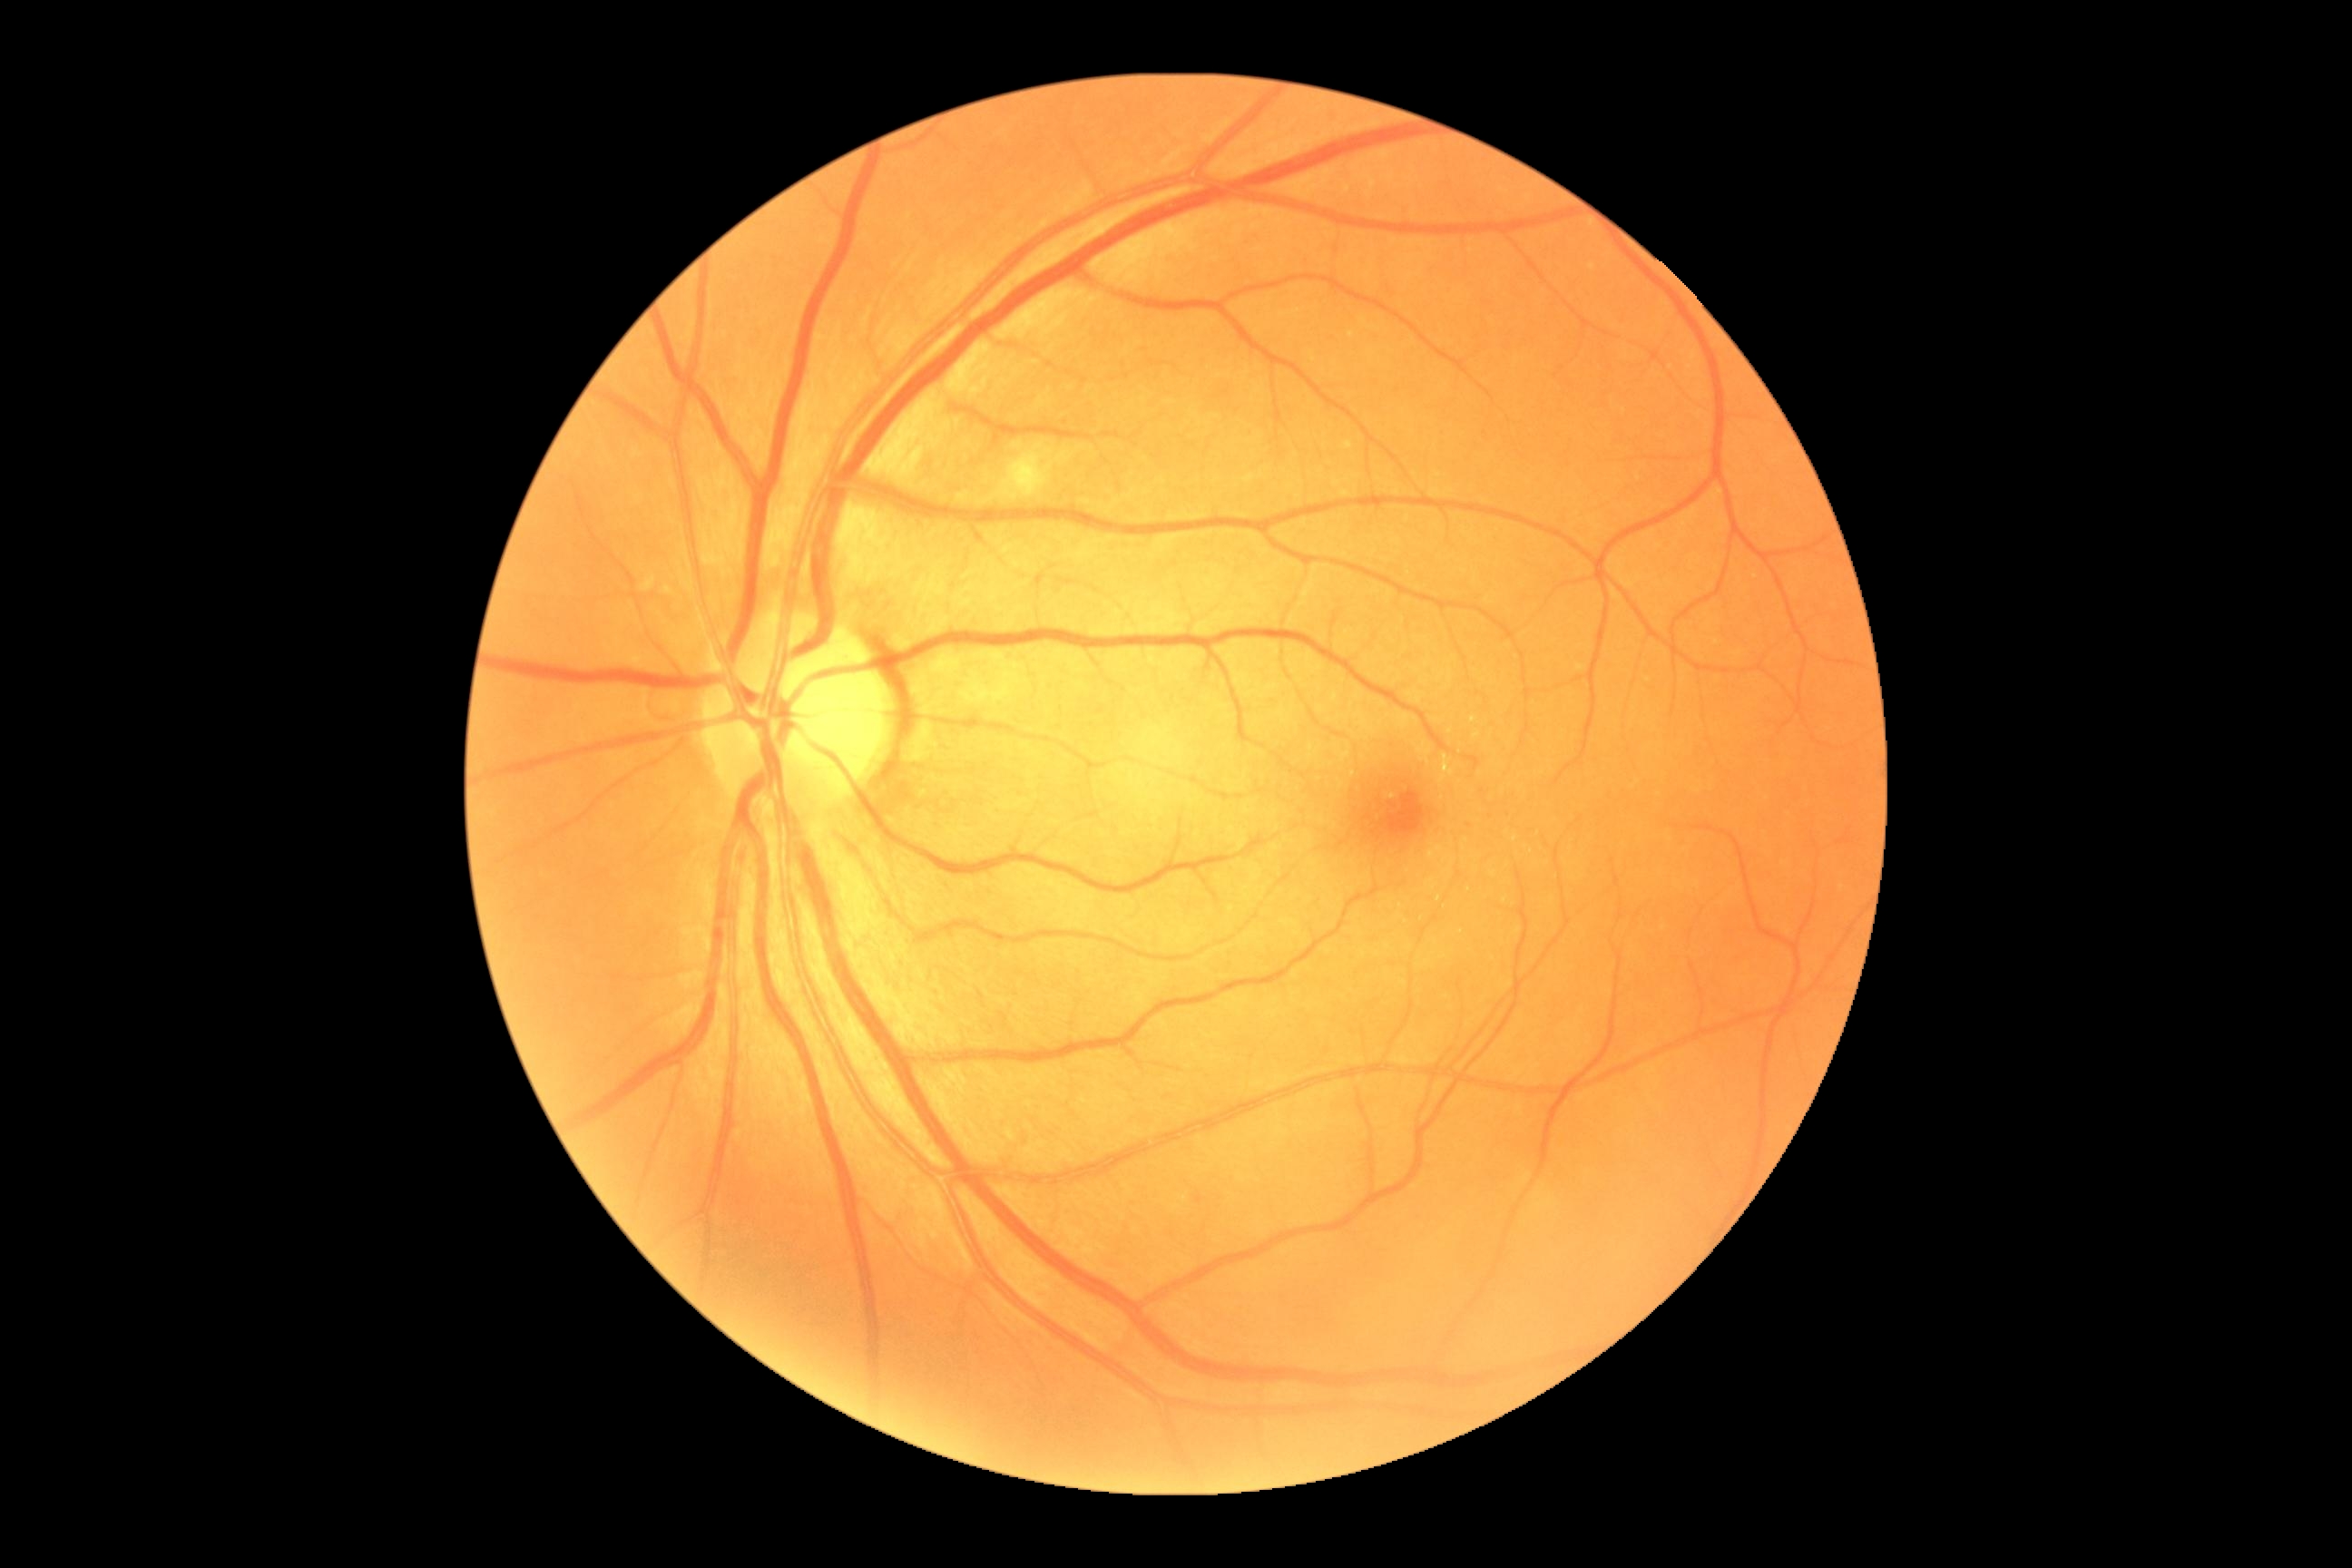 Diabetic retinopathy grade is 2.